Infant wide-field retinal image: 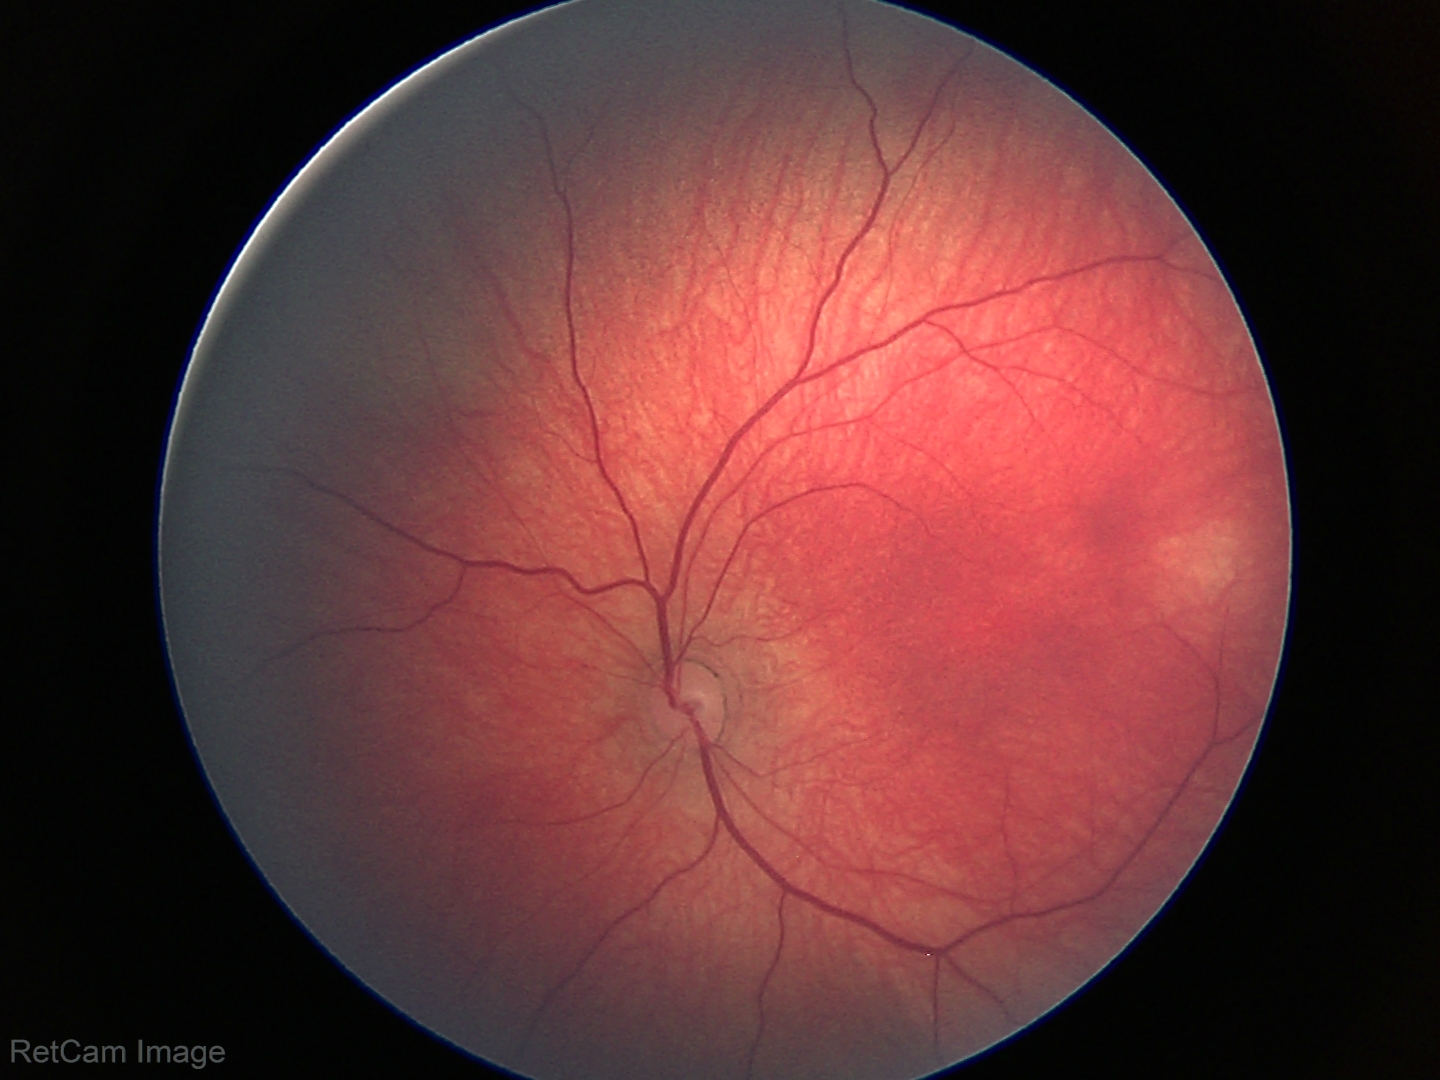

No retinal pathology identified on screening.